Image size 640x480 · infant wide-field retinal image
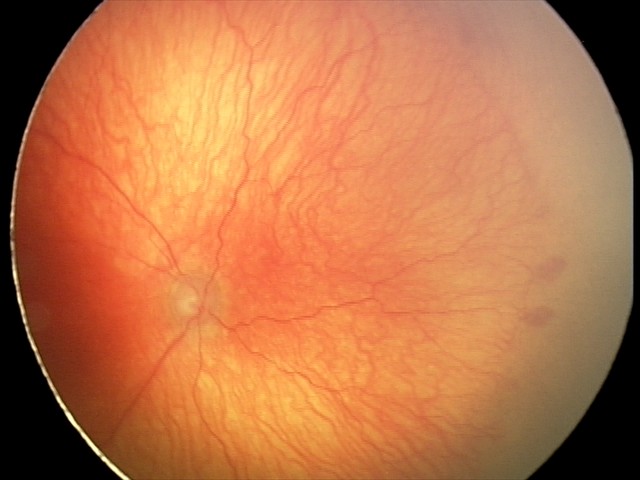
Plus disease present. Examination diagnosed as aggressive retinopathy of prematurity.